Without pupil dilation. 848x848px. 45° field of view. NIDEK AFC-230 — 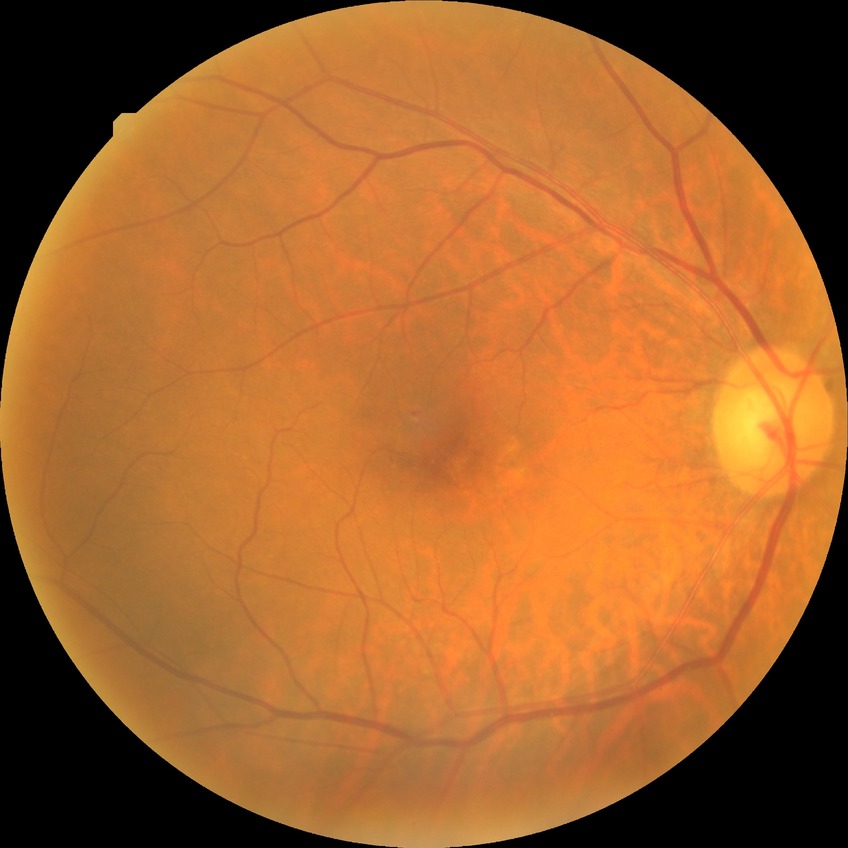
retinopathy stage@simple diabetic retinopathy; DR class@non-proliferative diabetic retinopathy.